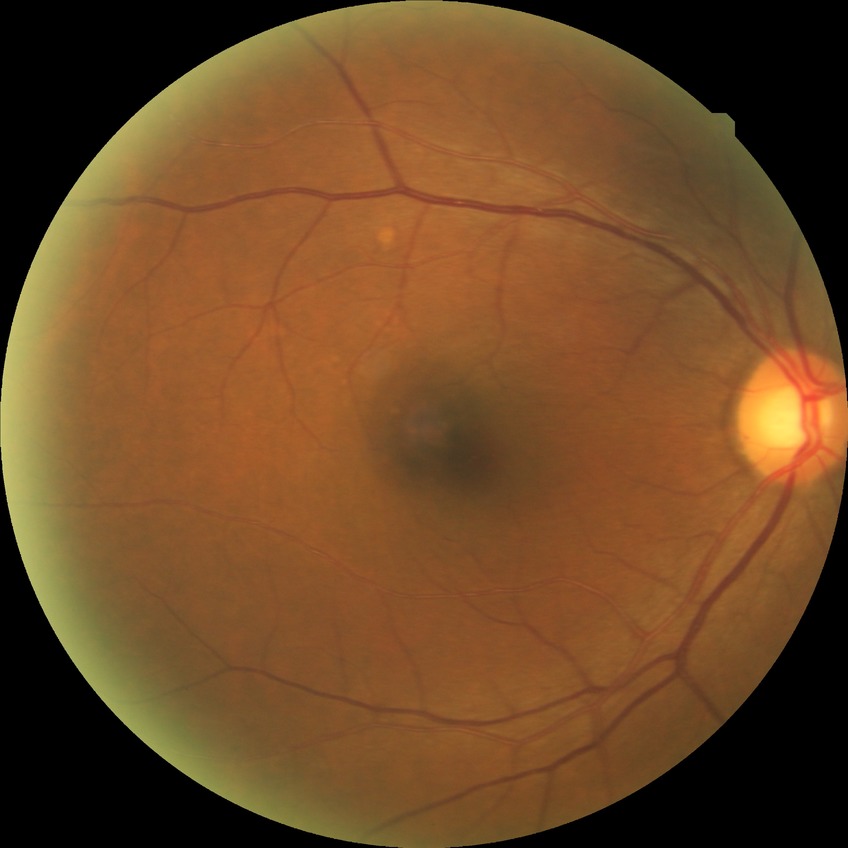
Diabetic retinopathy (DR): NDR (no diabetic retinopathy).